2352 x 1568 pixels
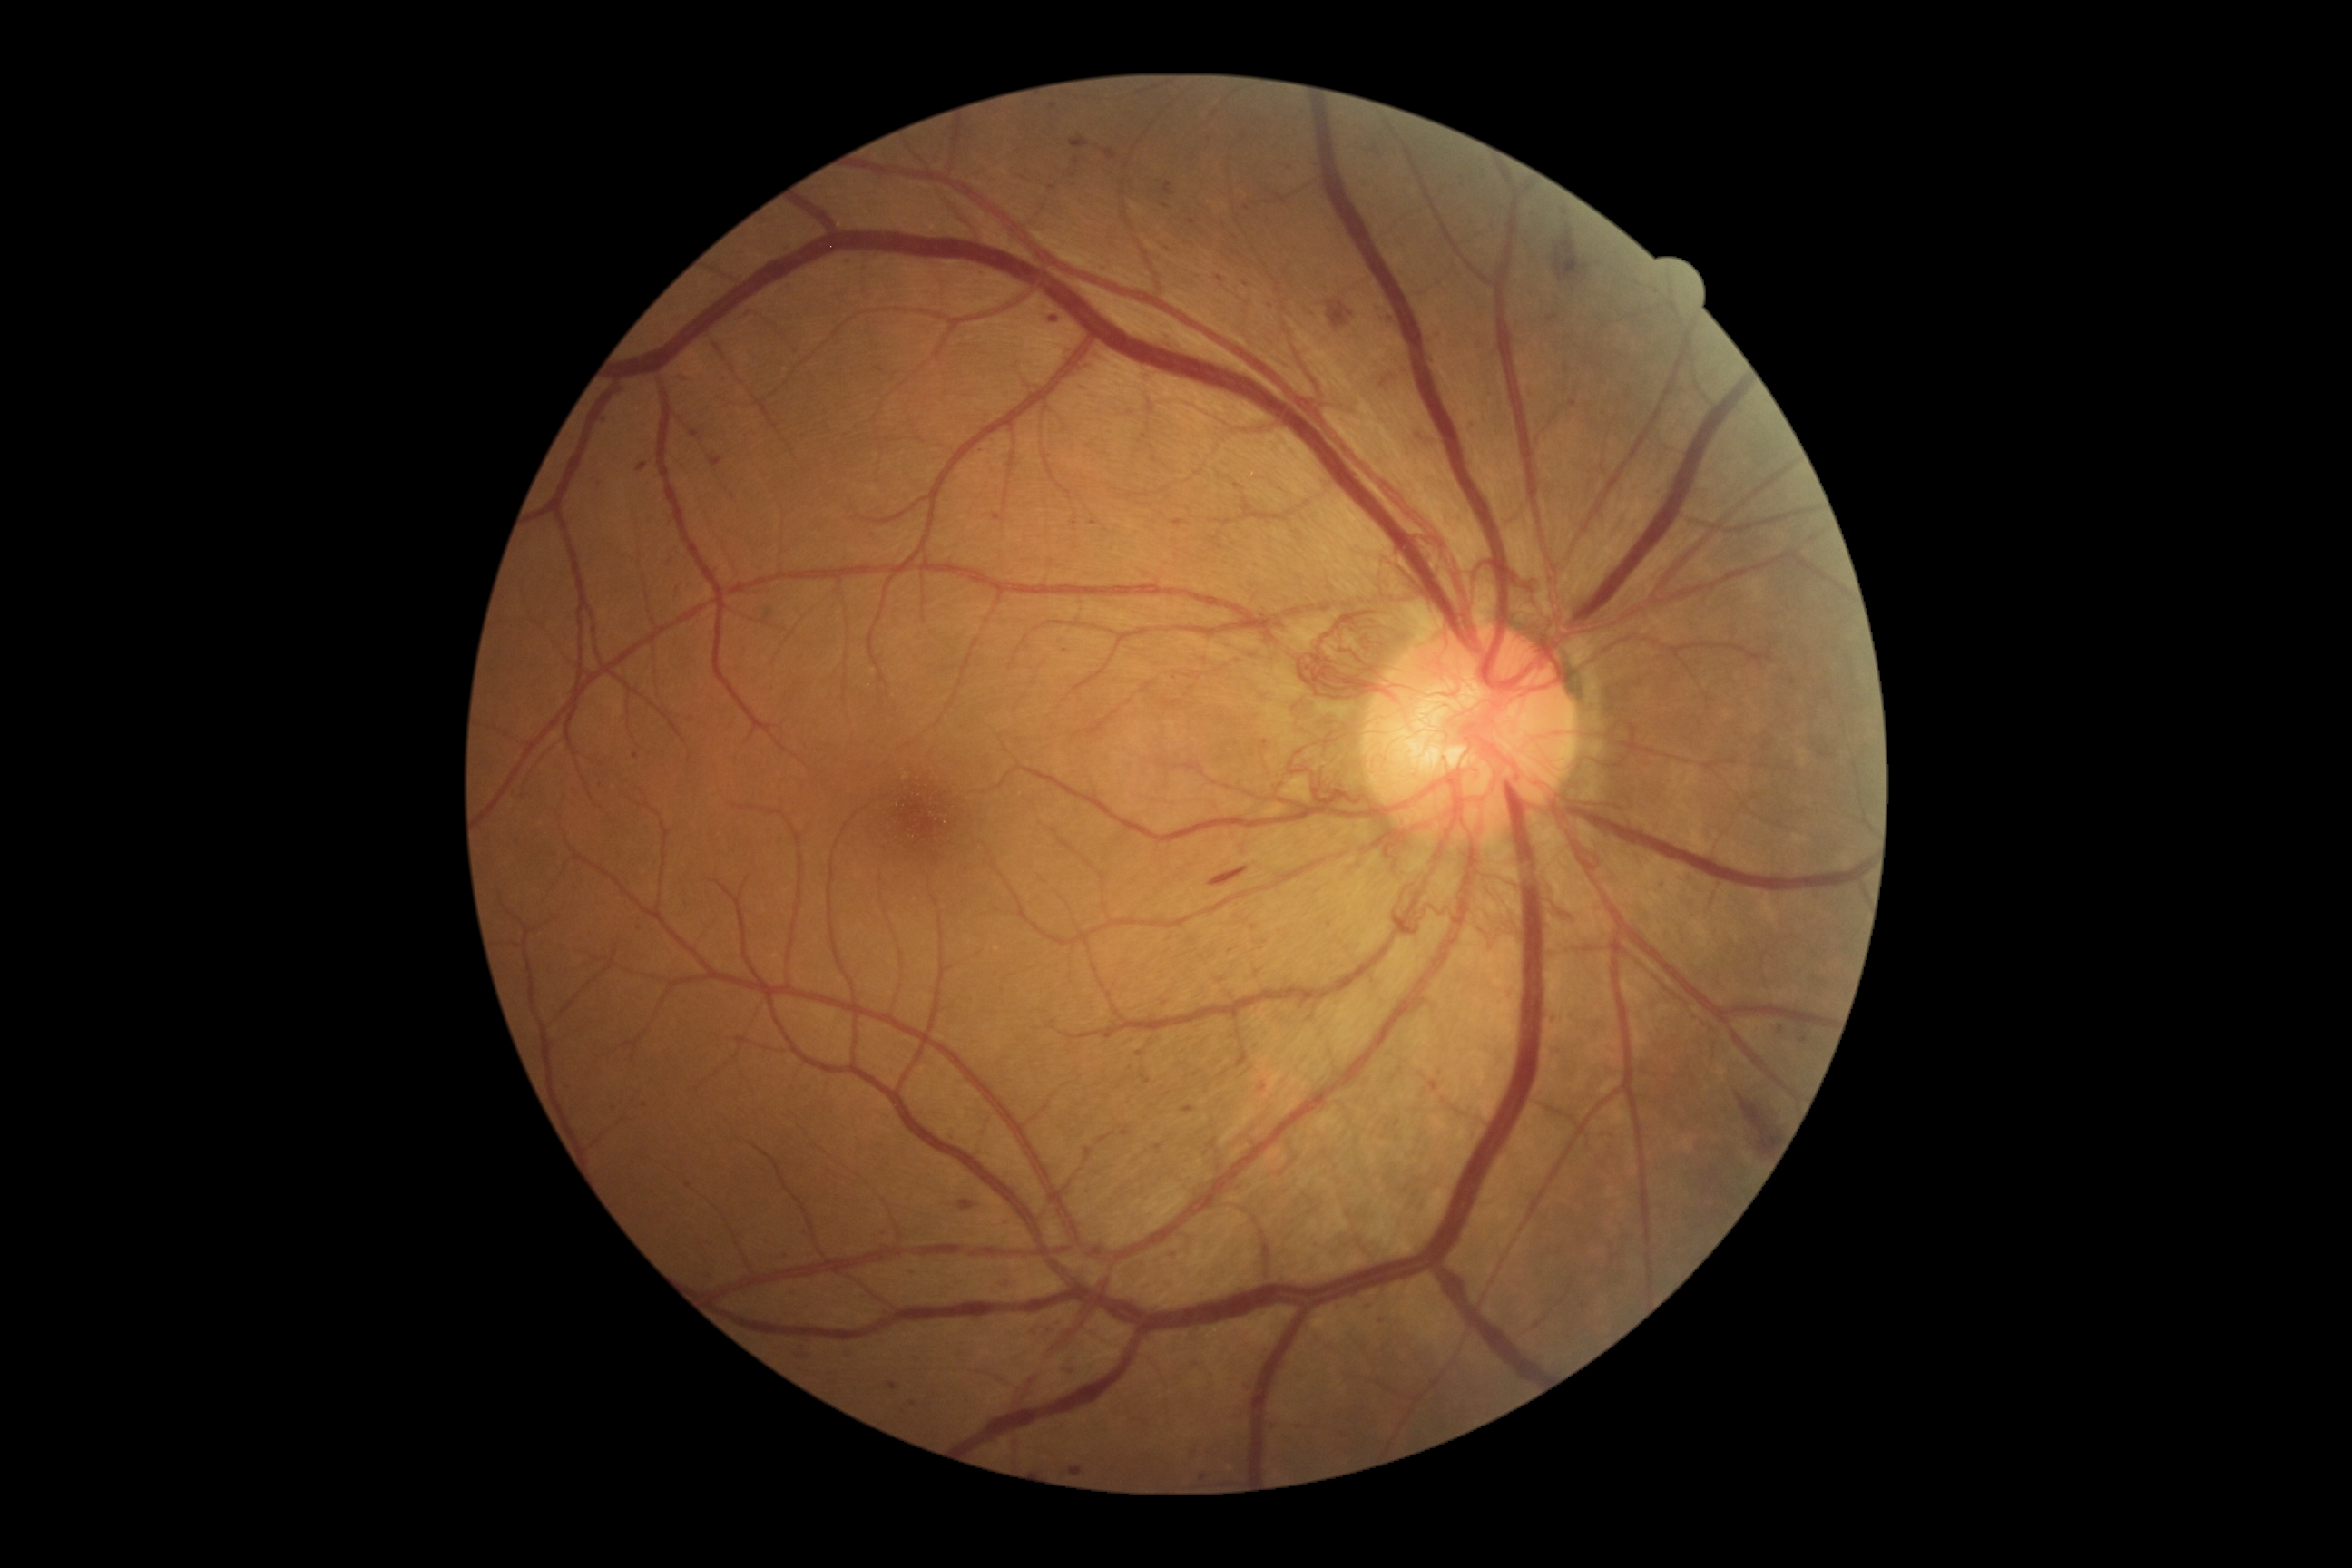 partial: true
dr_grade: 4
dr_grade_name: PDR
lesions:
  ma:
    - x1=1121, y1=1130, x2=1132, y2=1135
    - x1=1161, y1=328, x2=1173, y2=335
    - x1=1104, y1=1035, x2=1113, y2=1041
    - x1=1415, y1=431, x2=1422, y2=440
    - x1=634, y1=752, x2=640, y2=760
    - x1=843, y1=1351, x2=856, y2=1360
    - x1=1152, y1=456, x2=1159, y2=464
    - x1=790, y1=1288, x2=798, y2=1297
    - x1=1157, y1=1142, x2=1162, y2=1150
    - x1=1378, y1=1317, x2=1386, y2=1322
  ma_small:
    - 1329/925
    - 1804/1040
    - 983/452
    - 913/1404
    - 1075/176
    - 670/562
    - 1247/285
    - 914/1272
    - 1152/448
  he:
    - x1=1469, y1=420, x2=1475, y2=429
    - x1=1003, y1=1280, x2=1012, y2=1288
    - x1=1070, y1=137, x2=1090, y2=150
    - x1=1055, y1=1369, x2=1073, y2=1377
    - x1=1553, y1=226, x2=1589, y2=284
    - x1=1547, y1=315, x2=1558, y2=322
    - x1=959, y1=1202, x2=975, y2=1211
    - x1=1411, y1=433, x2=1422, y2=442
    - x1=1210, y1=867, x2=1250, y2=887
    - x1=1068, y1=1465, x2=1083, y2=1475
    - x1=1375, y1=308, x2=1384, y2=311
    - x1=1429, y1=353, x2=1433, y2=364
    - x1=1328, y1=302, x2=1355, y2=329
    - x1=676, y1=375, x2=694, y2=382
    - x1=1164, y1=184, x2=1175, y2=197
    - x1=1104, y1=148, x2=1117, y2=161
    - x1=636, y1=462, x2=649, y2=473
    - x1=1736, y1=1093, x2=1778, y2=1153
    - x1=1387, y1=317, x2=1395, y2=326
  he_small:
    - 1439/336
  se: []
  ex: []